Clarity RetCam 3, 130° FOV · wide-field fundus photograph of an infant — 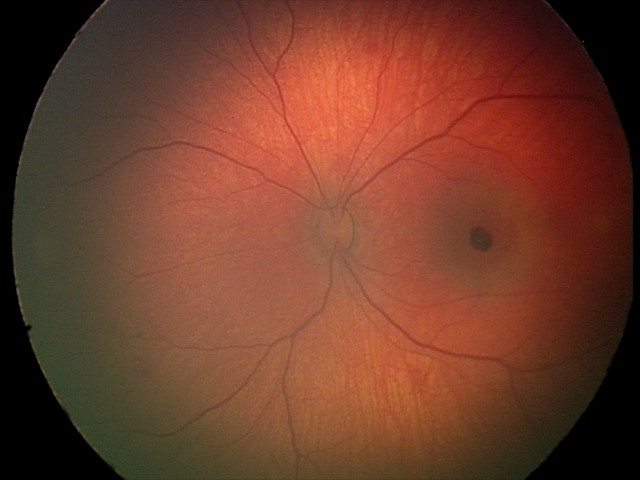

Screening series with retinal hemorrhages.